Retinal fundus photograph — 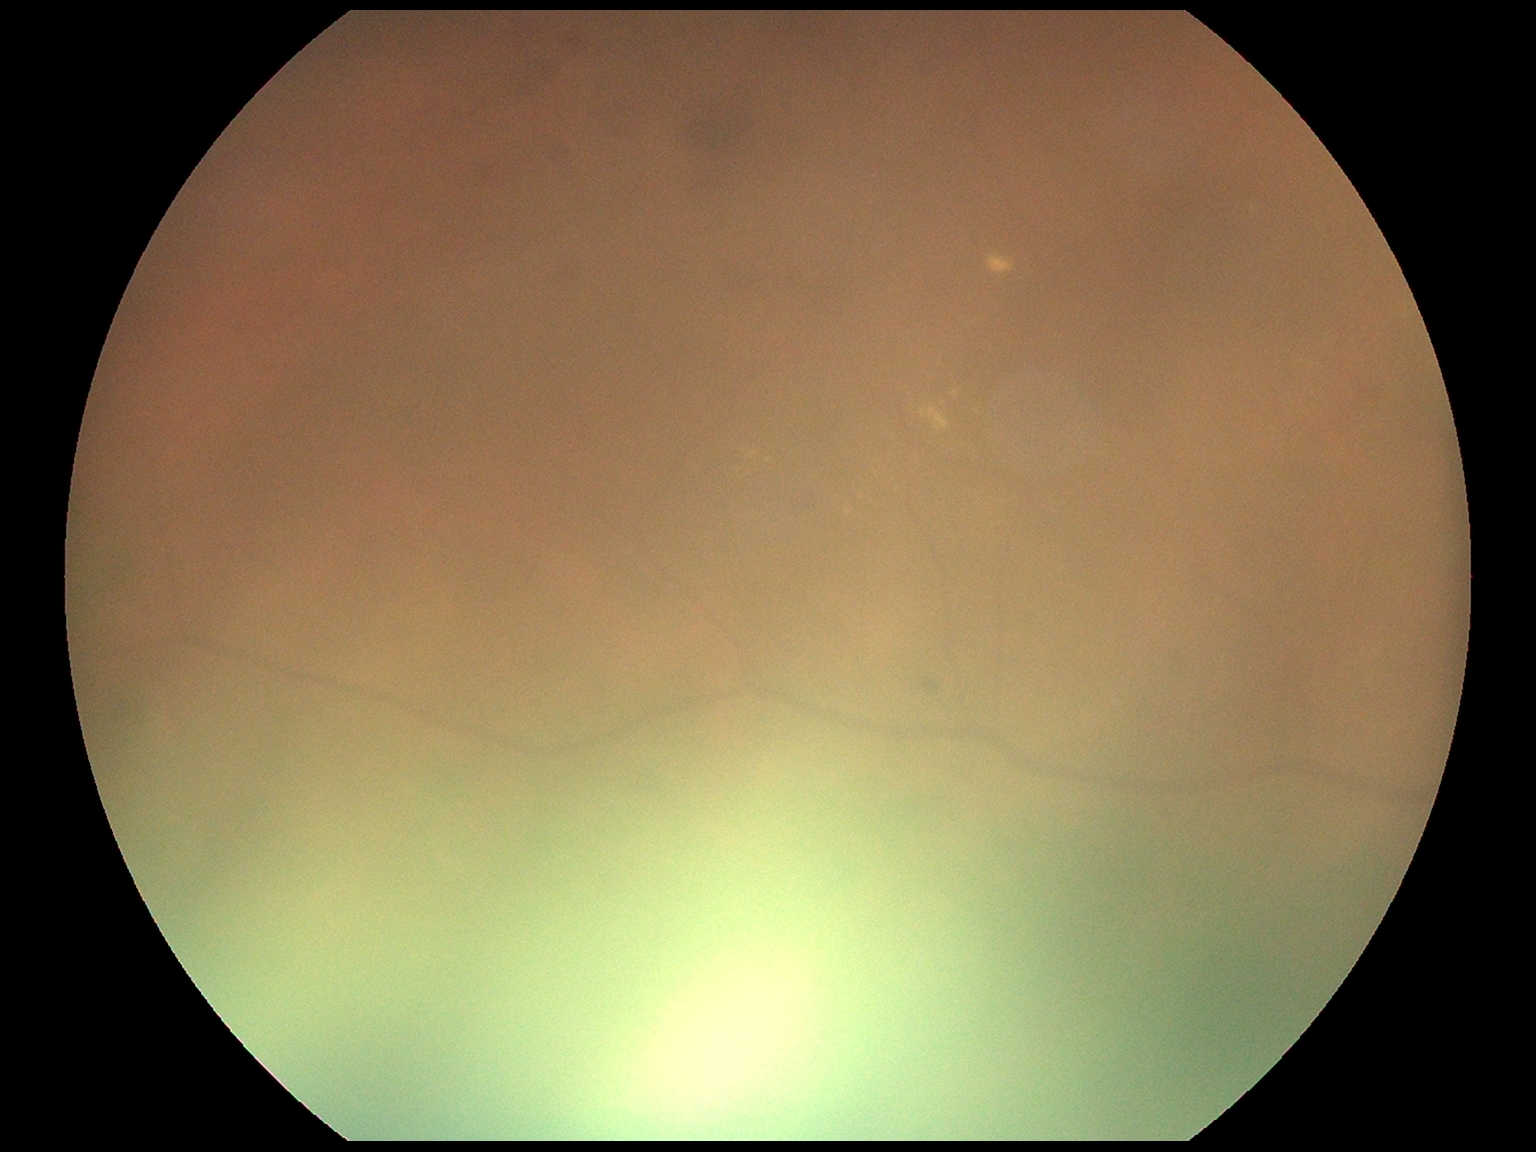

DR class = non-proliferative diabetic retinopathy, DR = moderate NPDR (grade 2) — more than just microaneurysms but less than severe NPDR.